45-degree field of view, Davis DR grading, 848x848 — 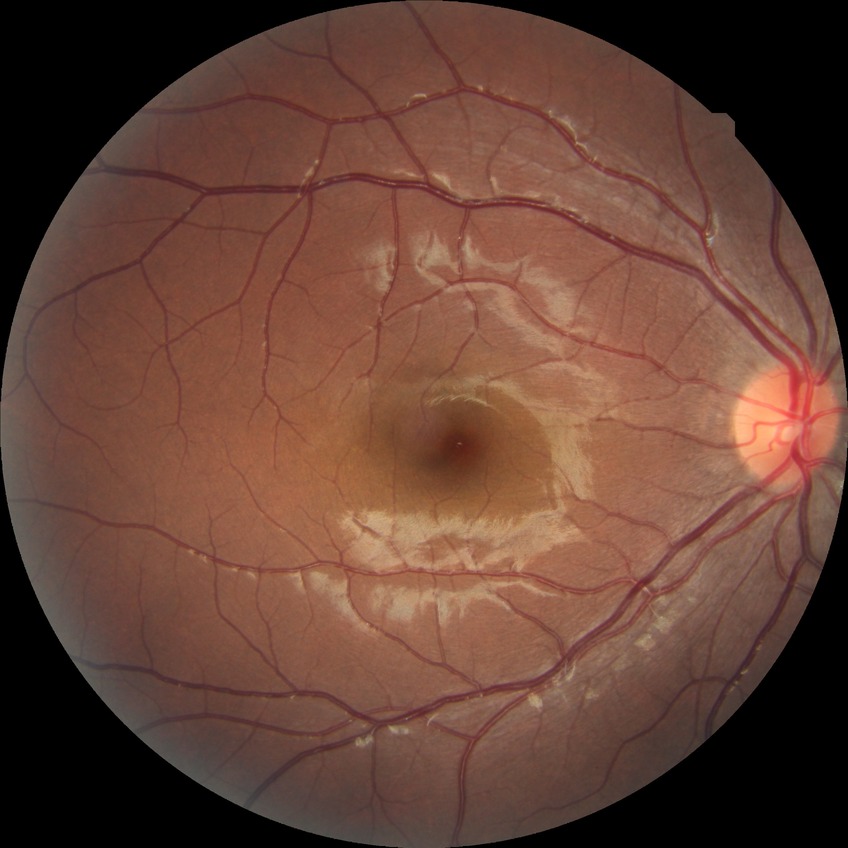 Assessment:
• diabetic retinopathy (DR): no diabetic retinopathy (NDR)